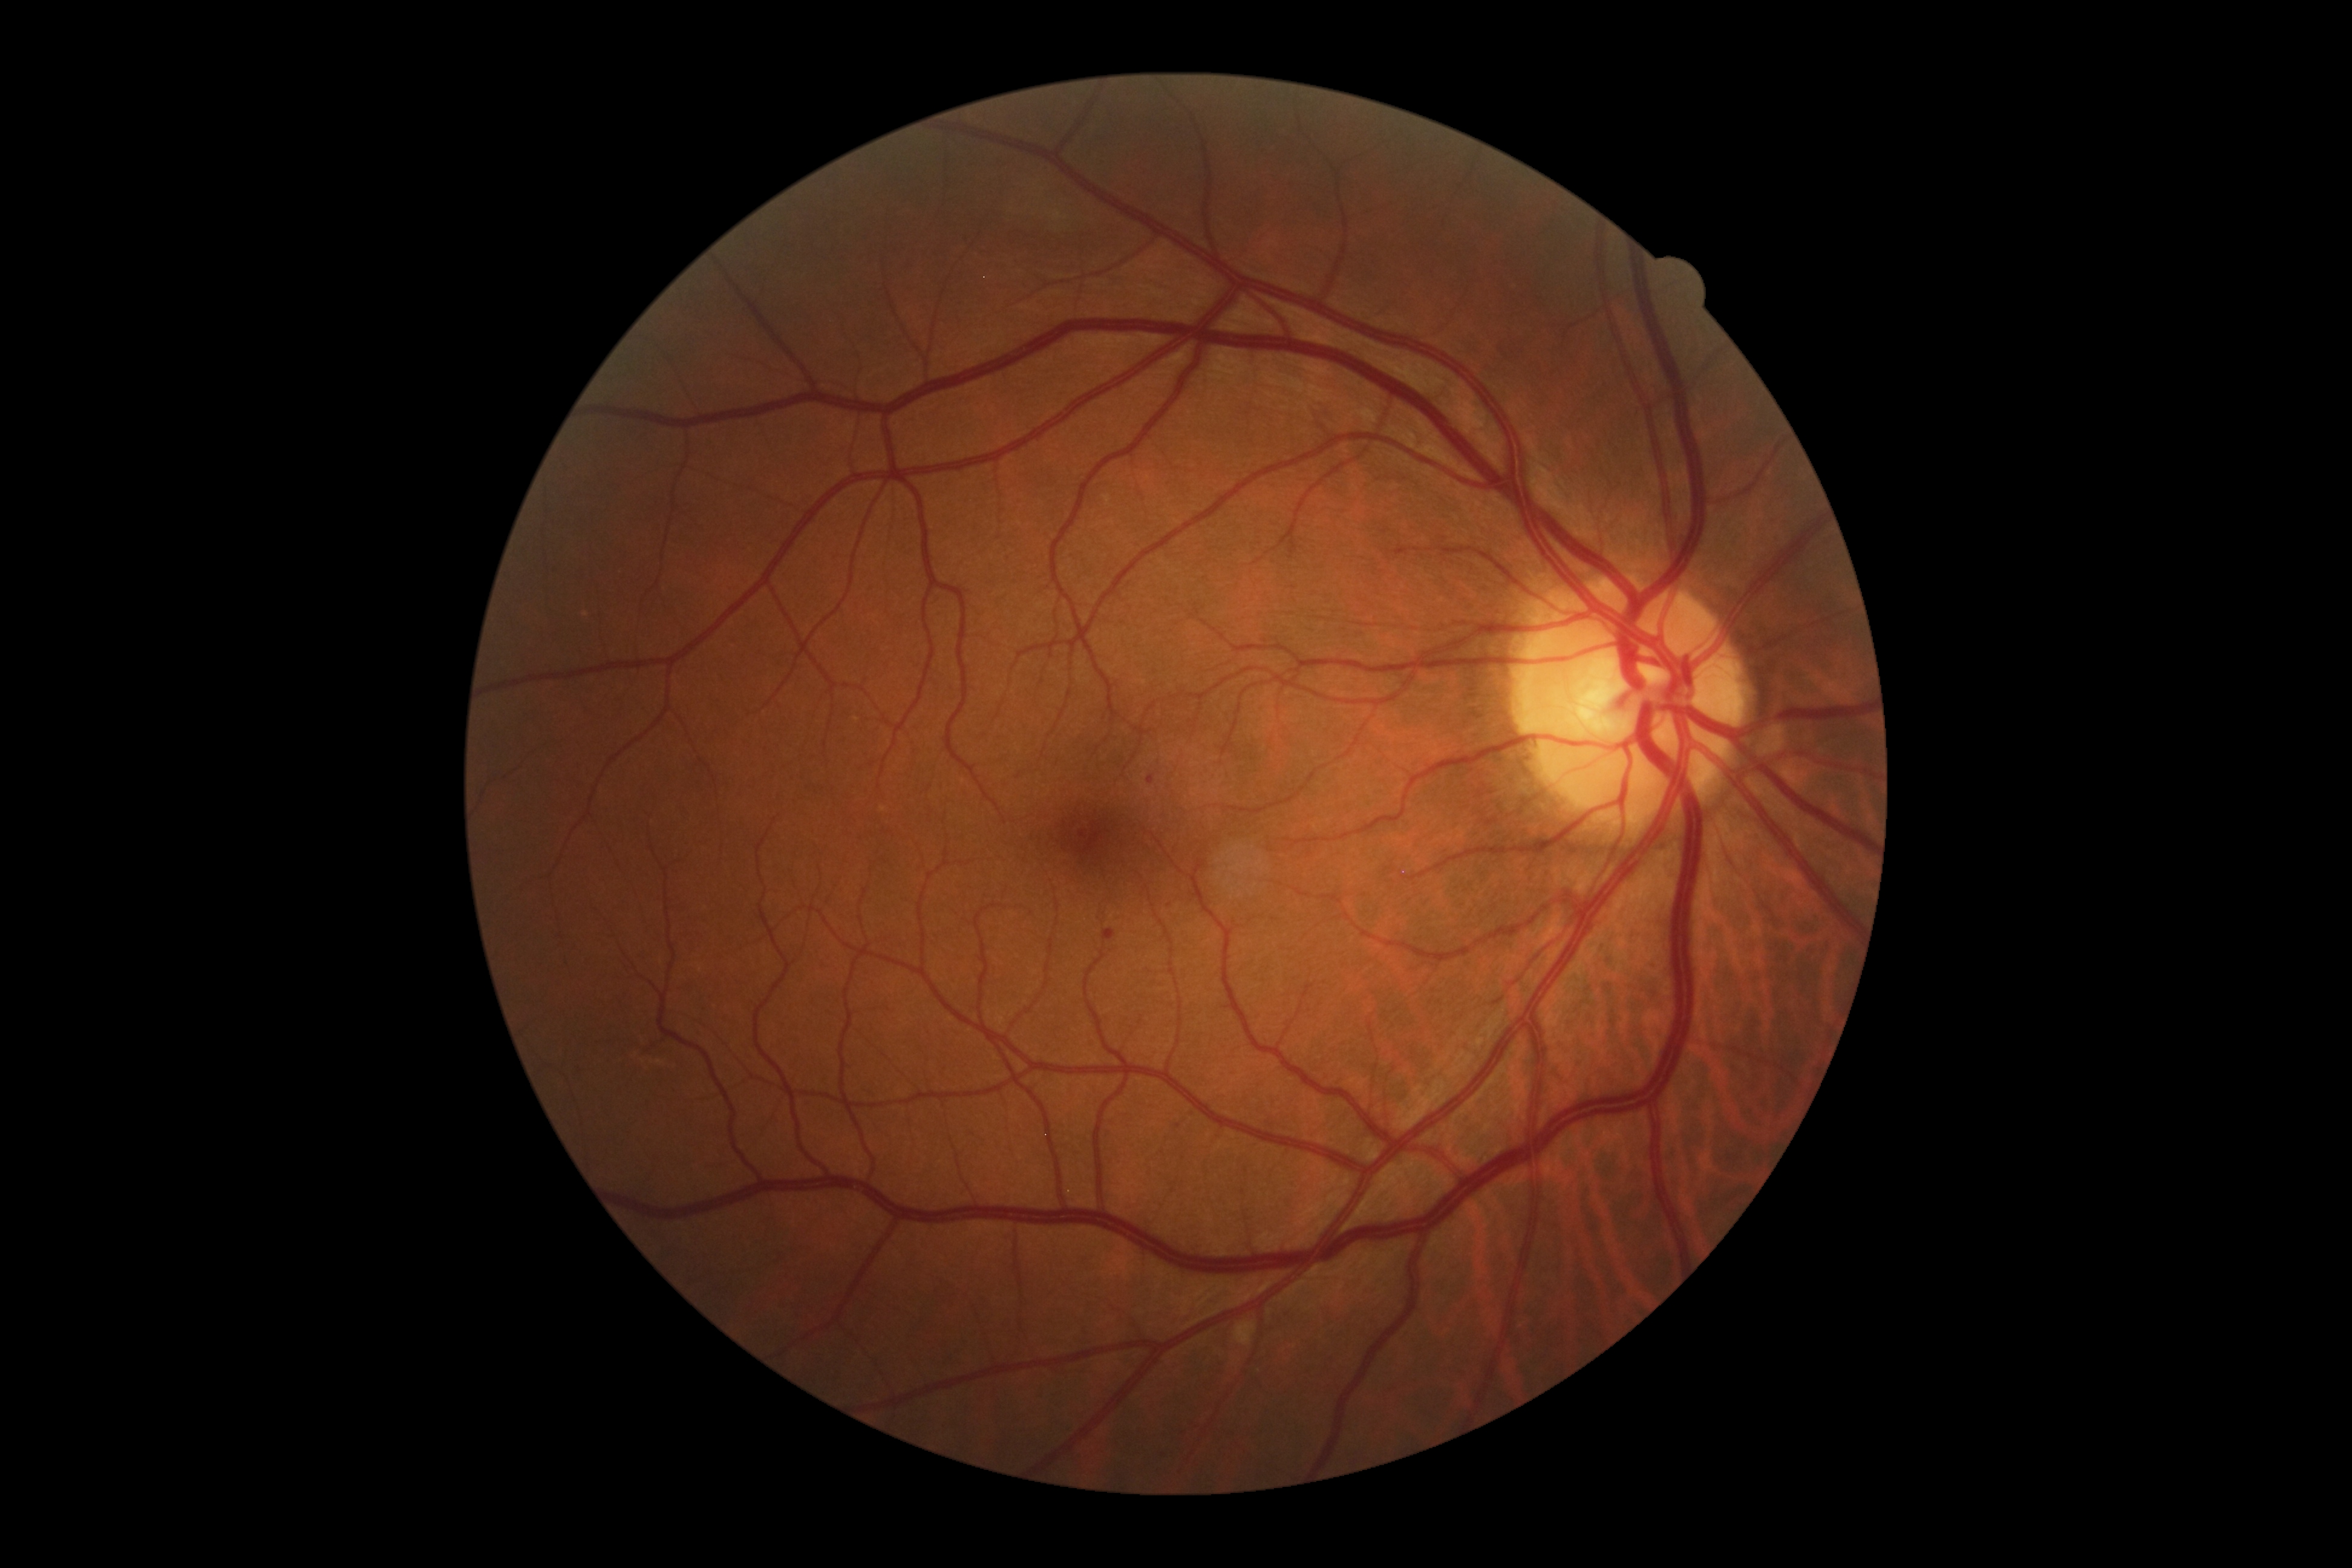

DR stage is 2/4.